Pediatric retinal photograph (wide-field): 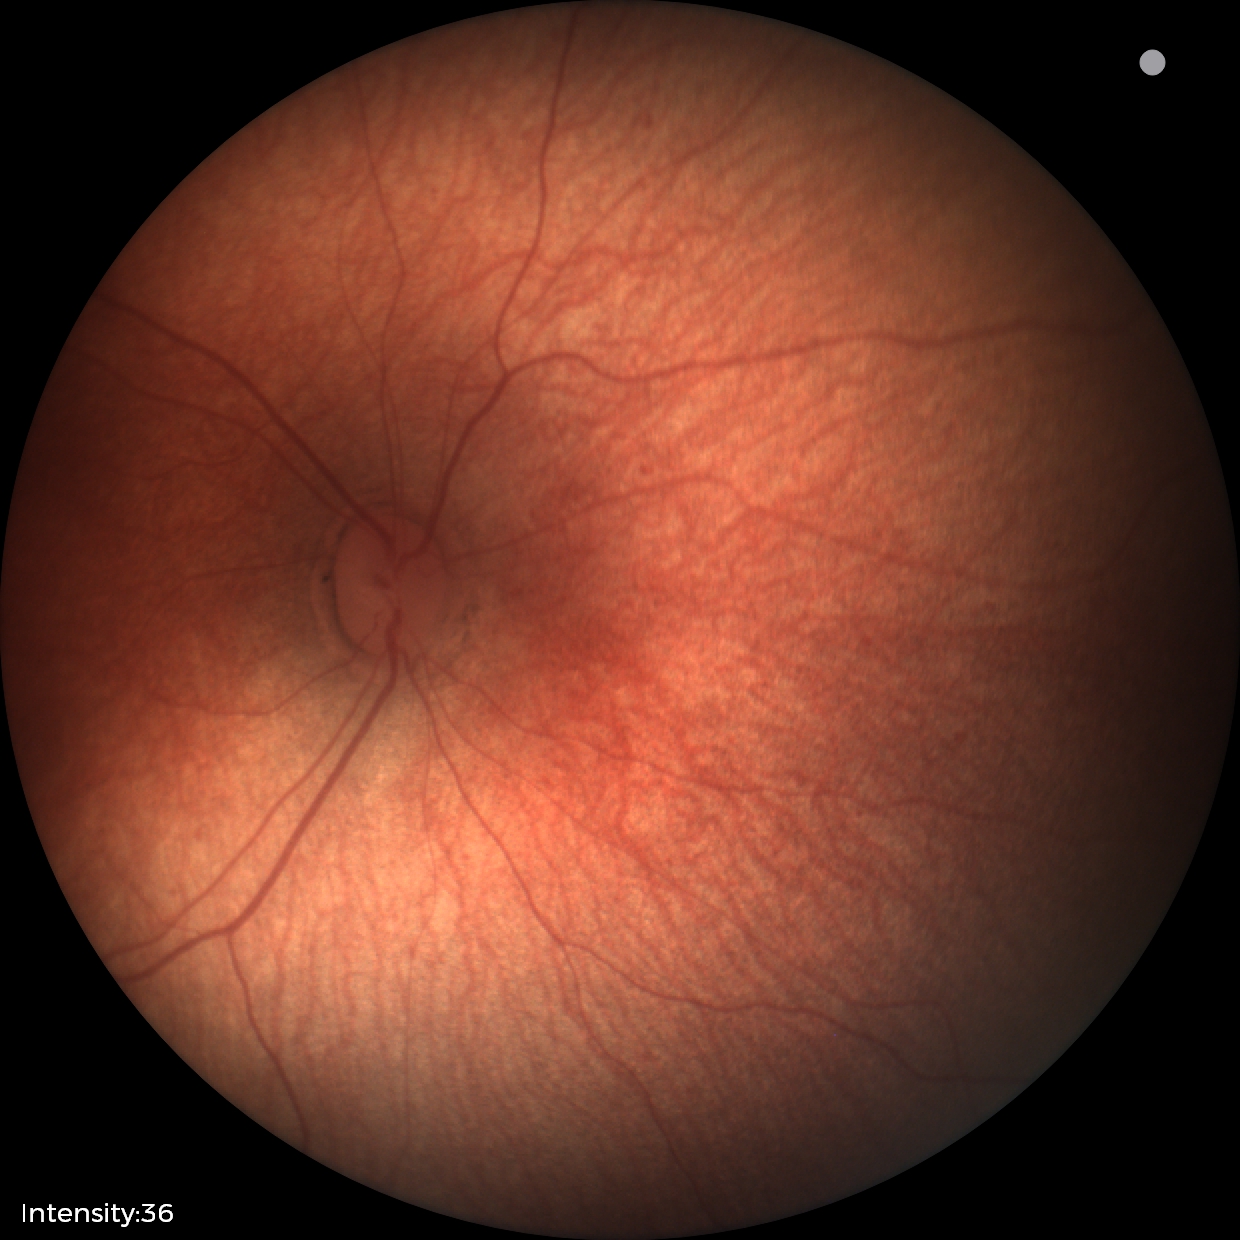

Normal screening examination.